Fundus photo; 1932x1916; FOV: 45 degrees:
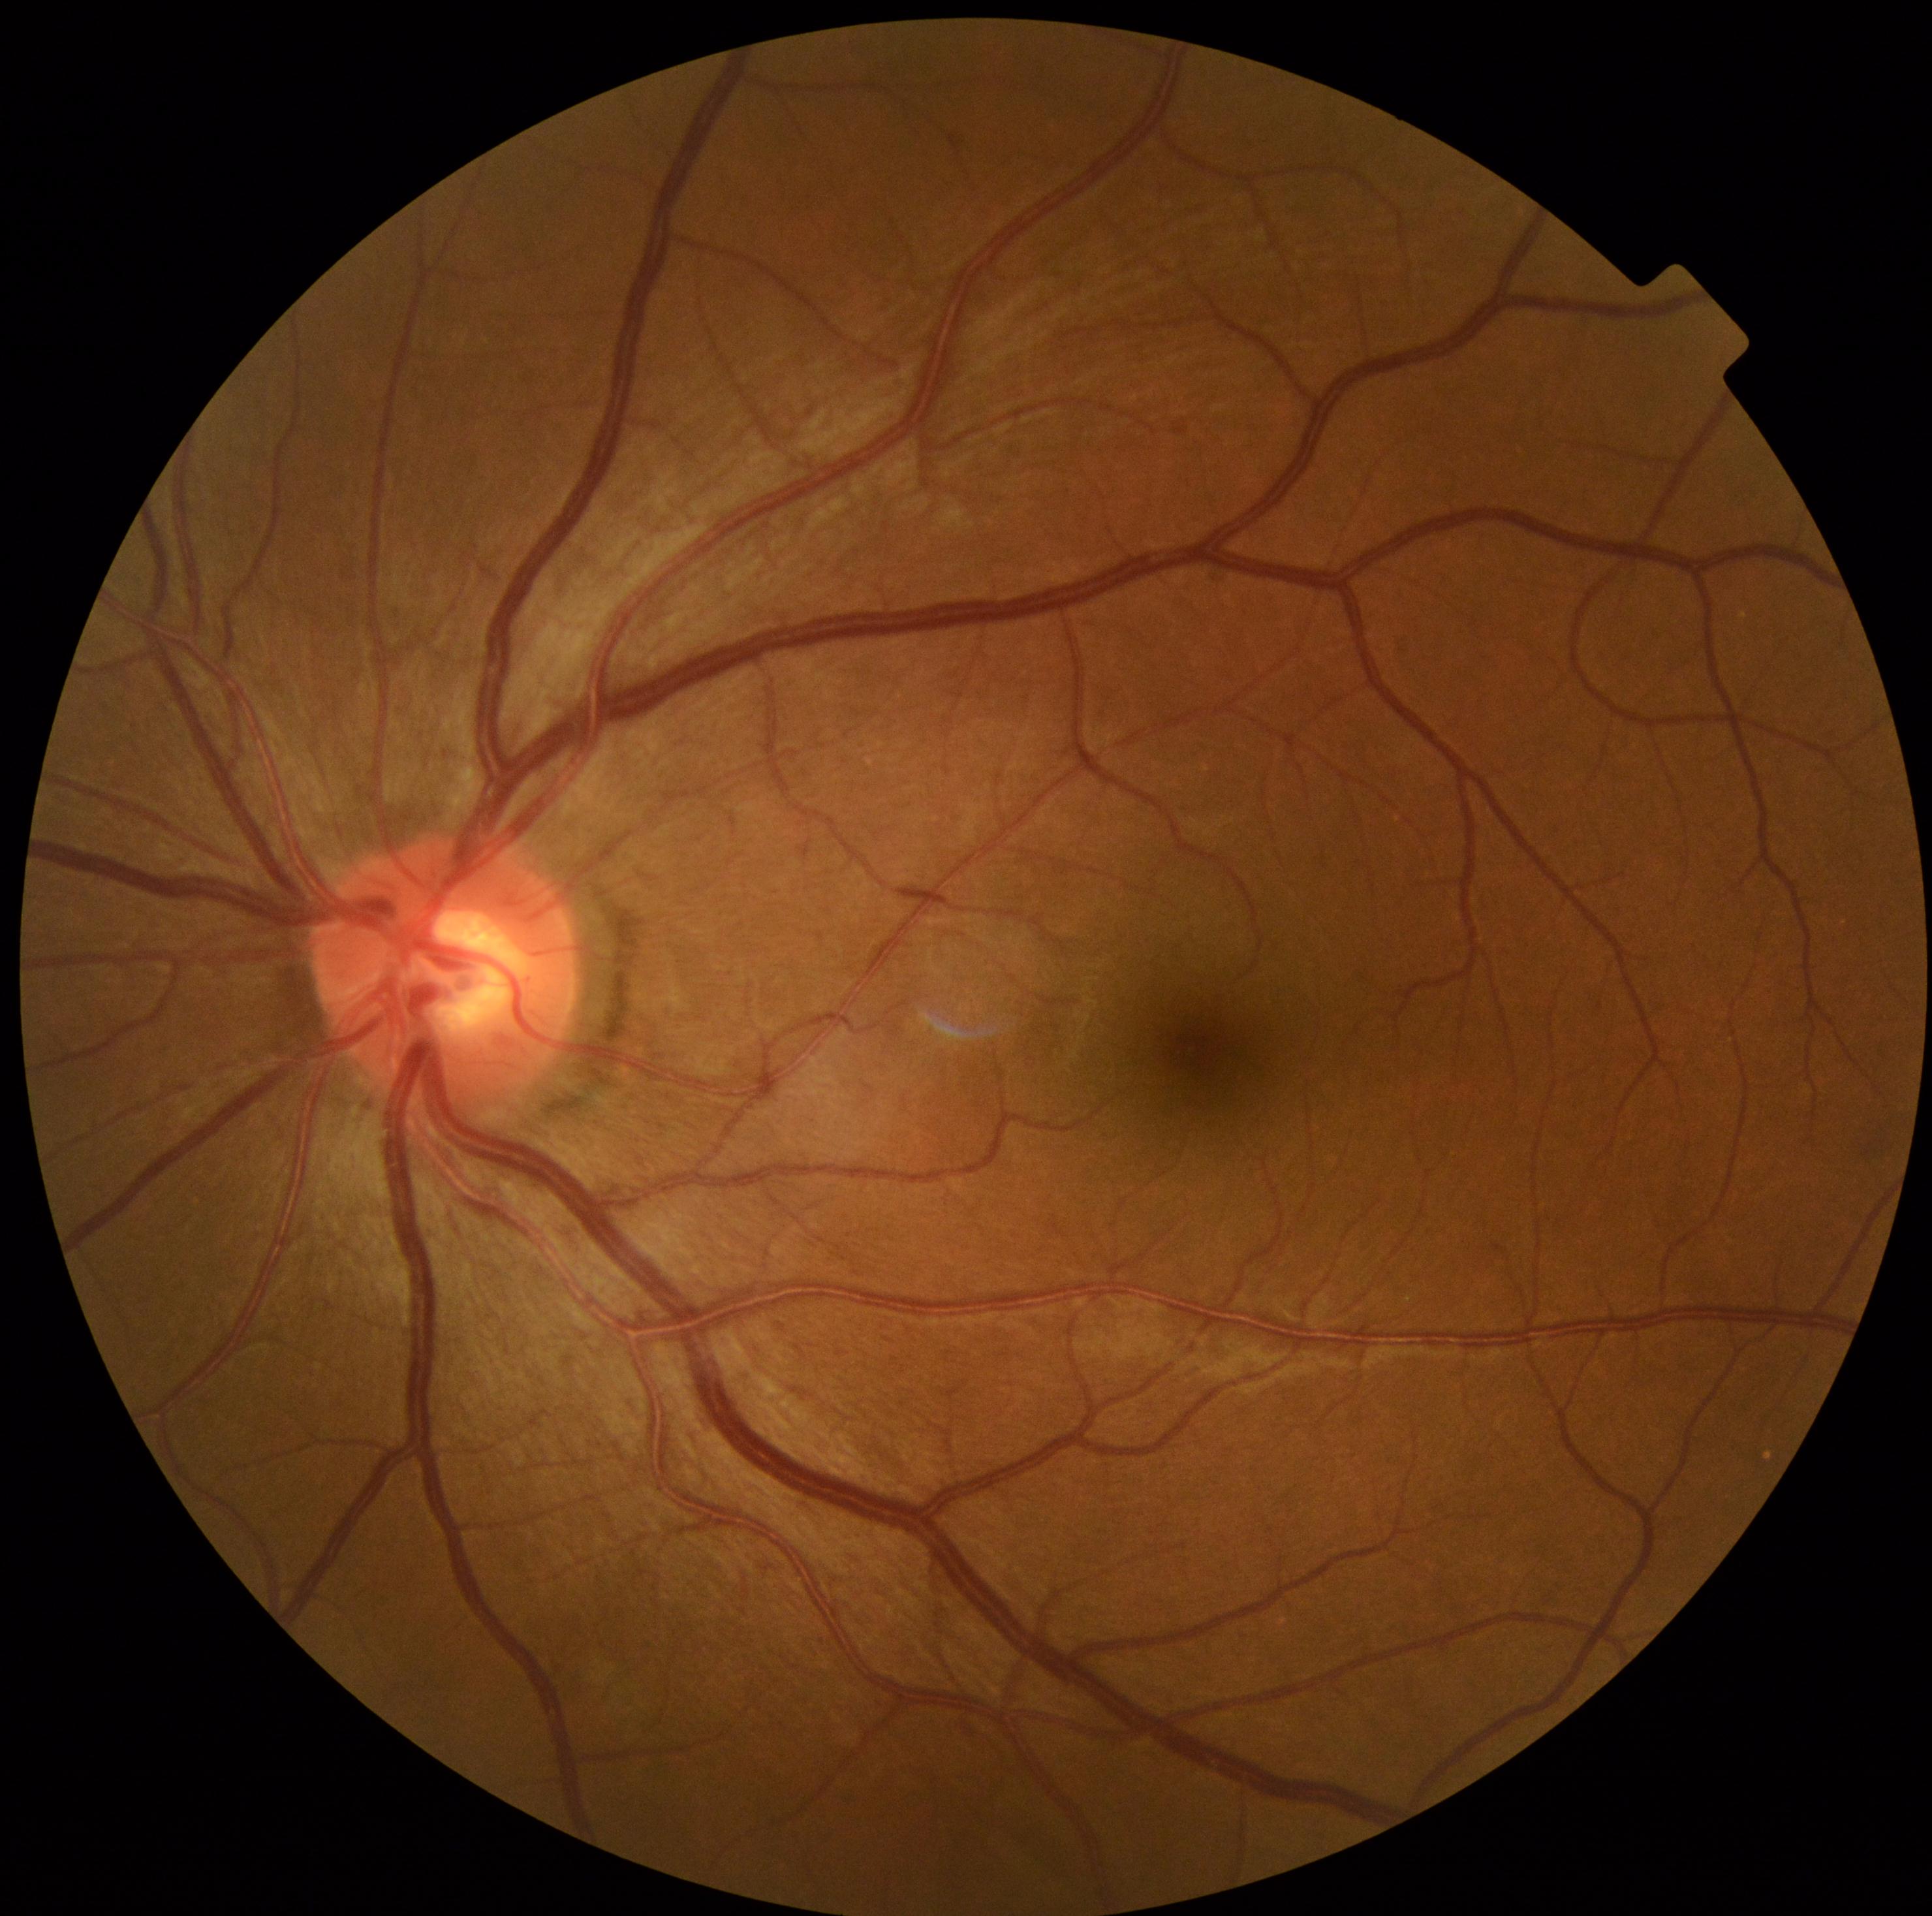 Diabetic retinopathy severity is no apparent retinopathy (grade 0) — no visible signs of diabetic retinopathy.